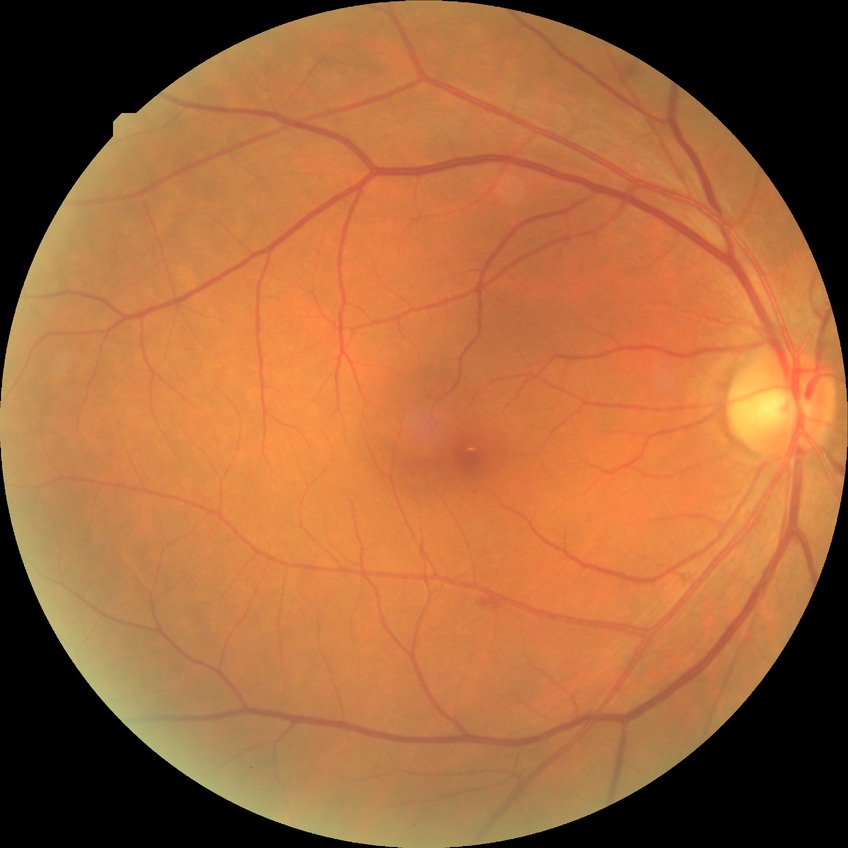

DR class = non-proliferative diabetic retinopathy
diabetic retinopathy (DR) = simple diabetic retinopathy (SDR)